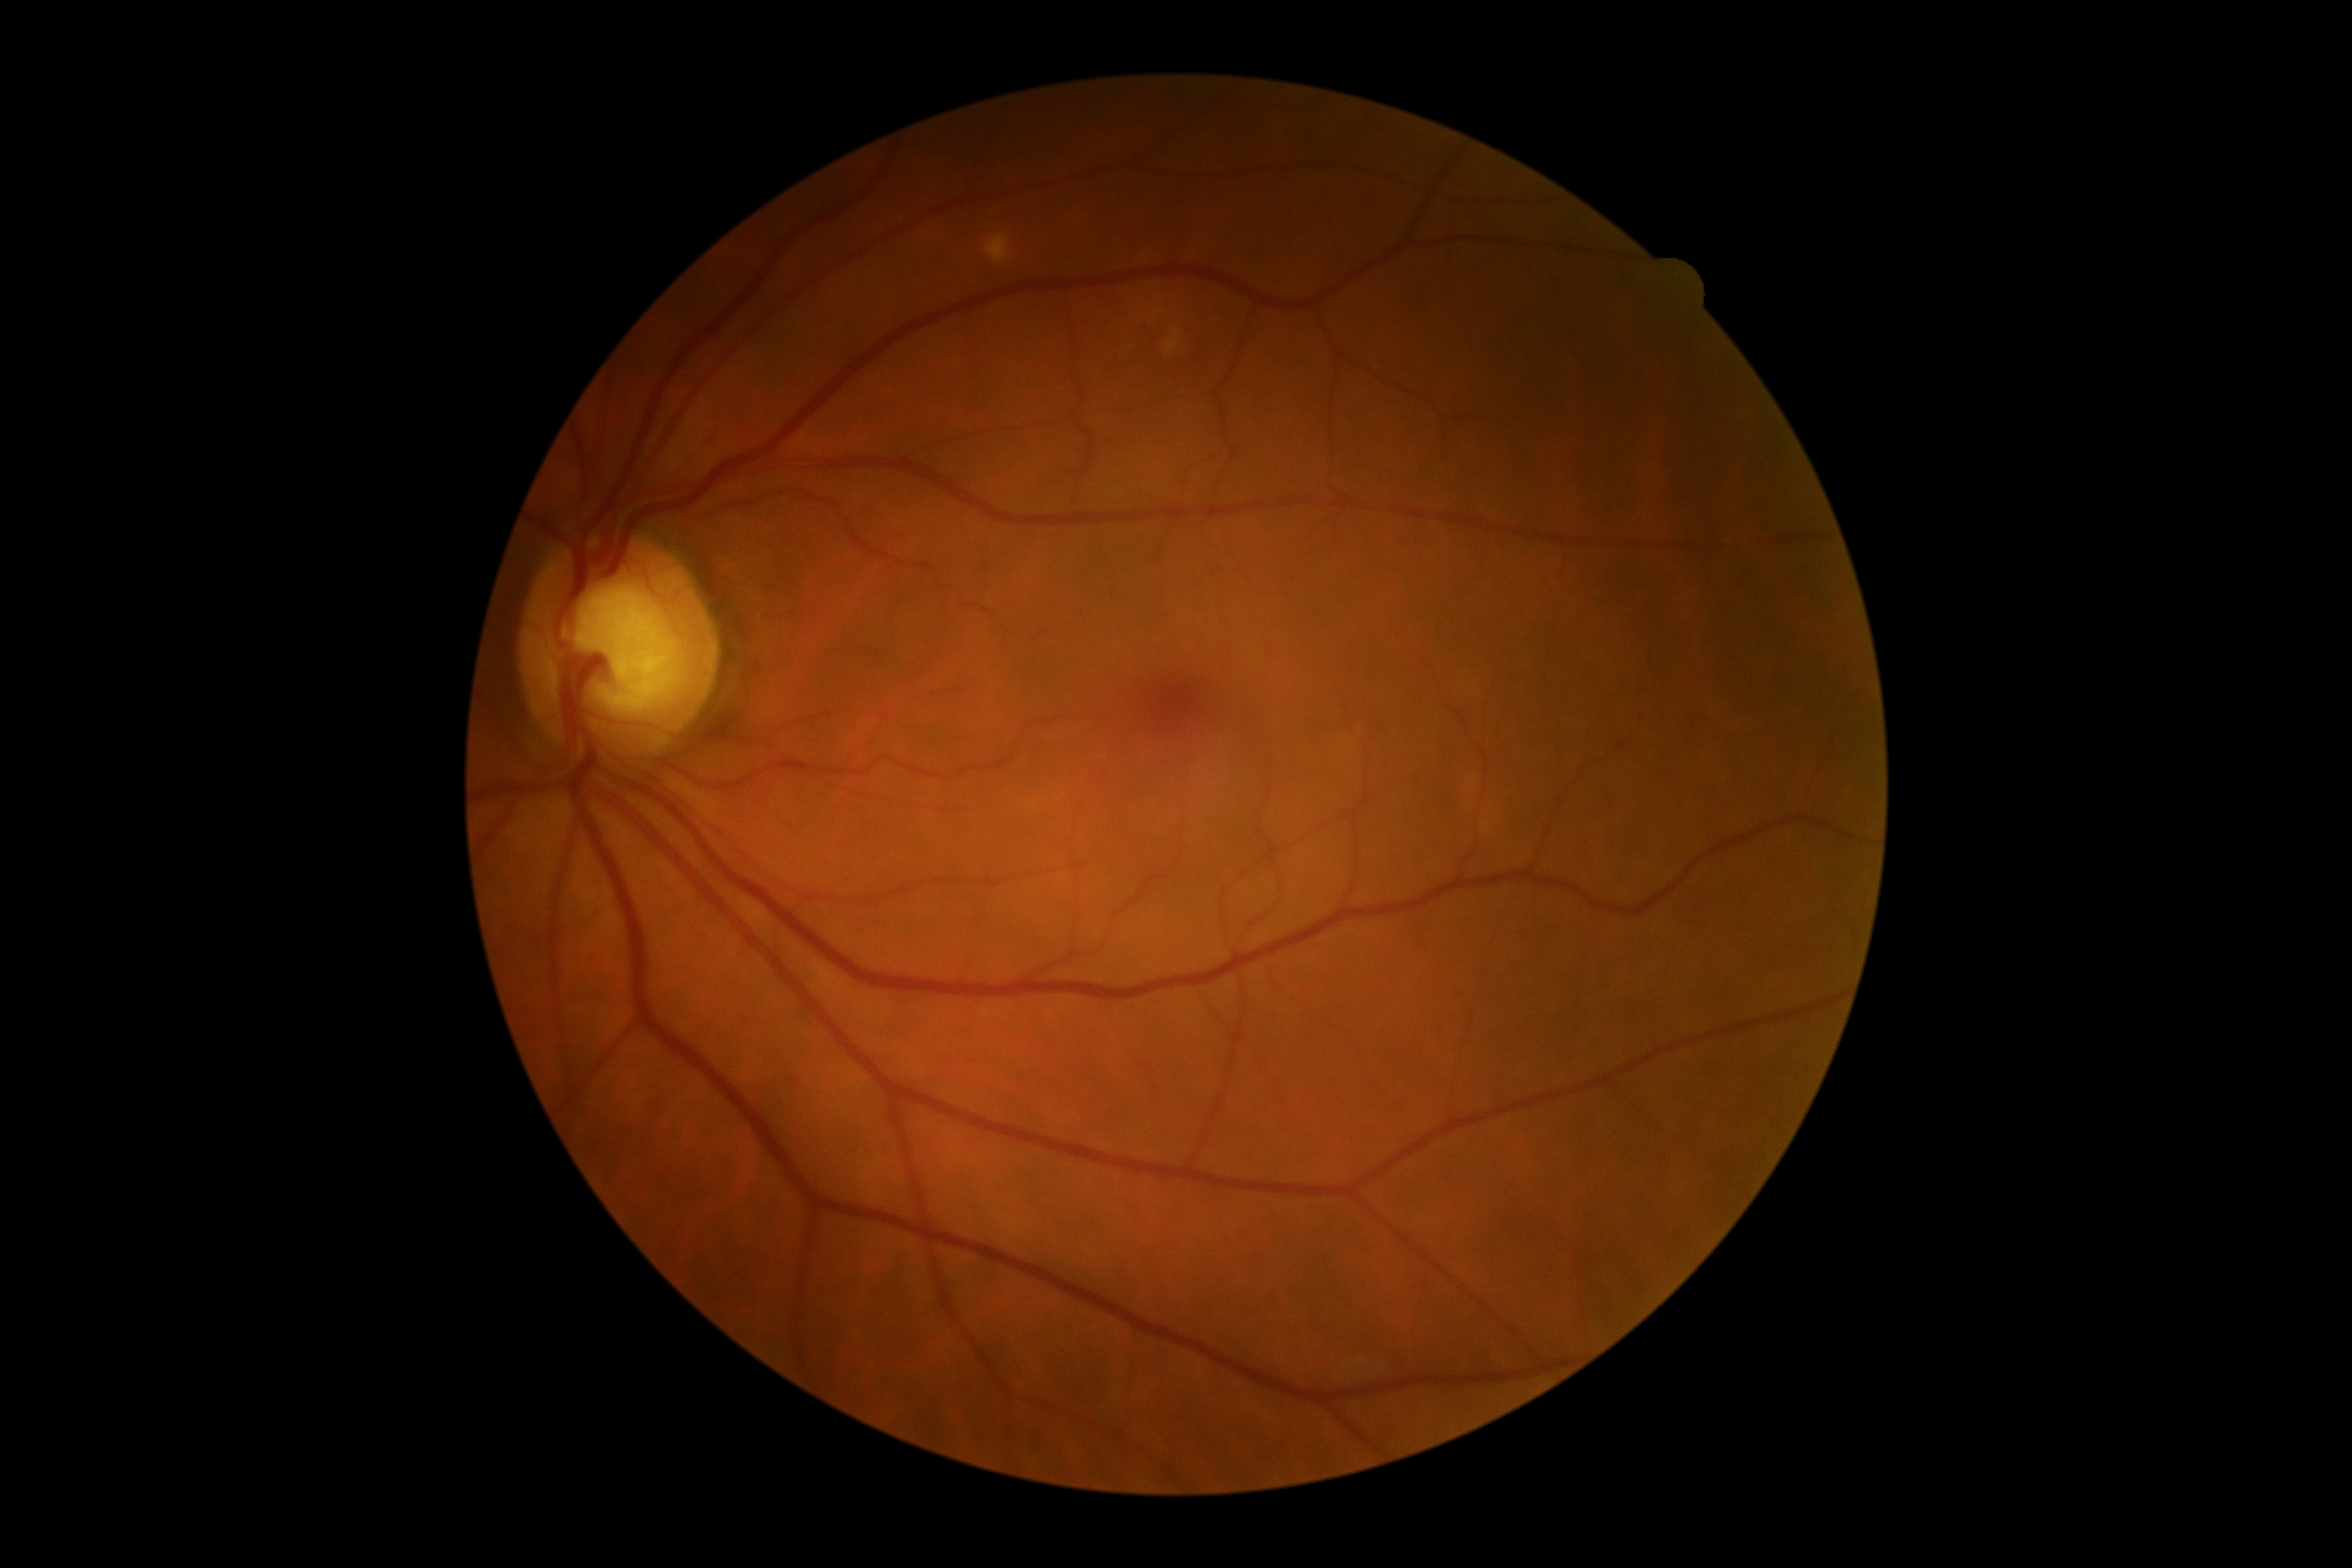

DR stage is grade 0.